Wide-field contact fundus photograph of an infant — 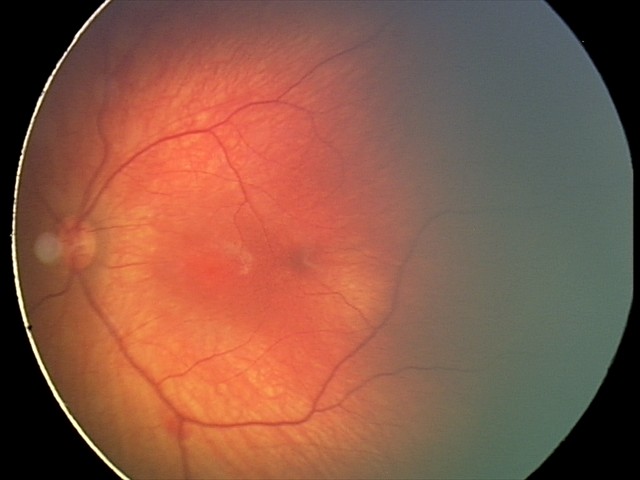 Finding = retinal hemorrhages.